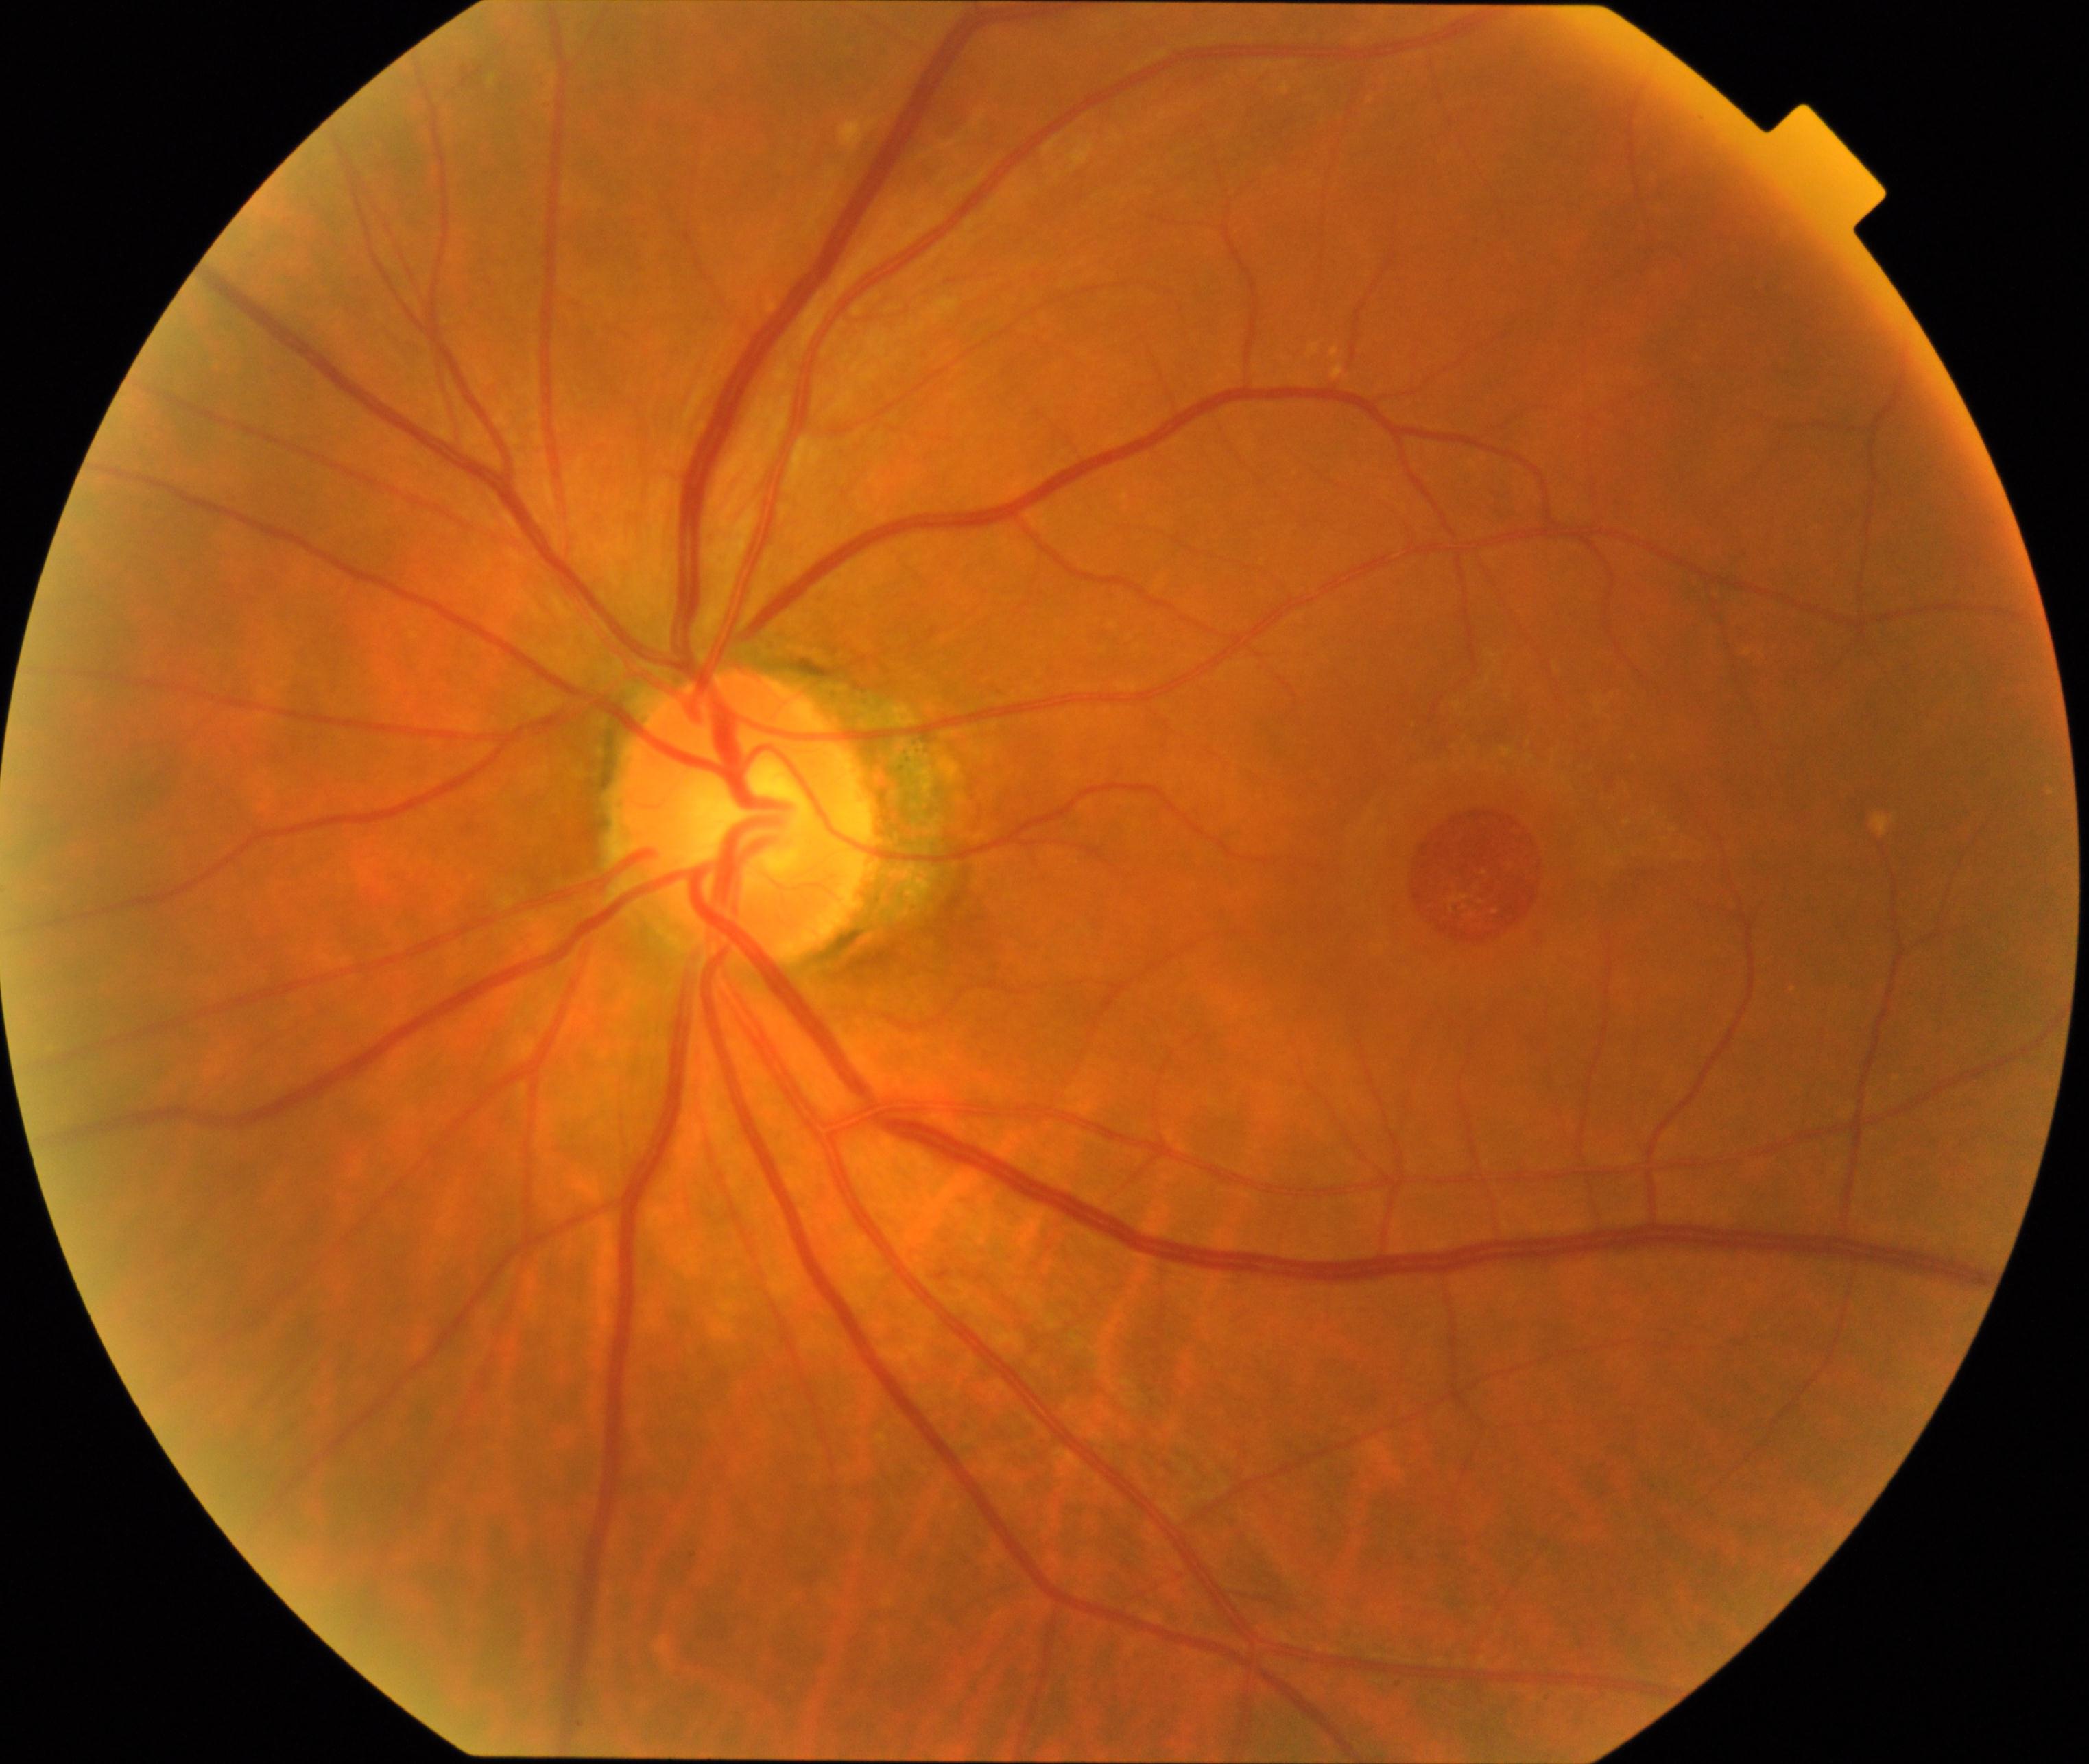

Diagnosis: MH (macular hole).